2352x1568
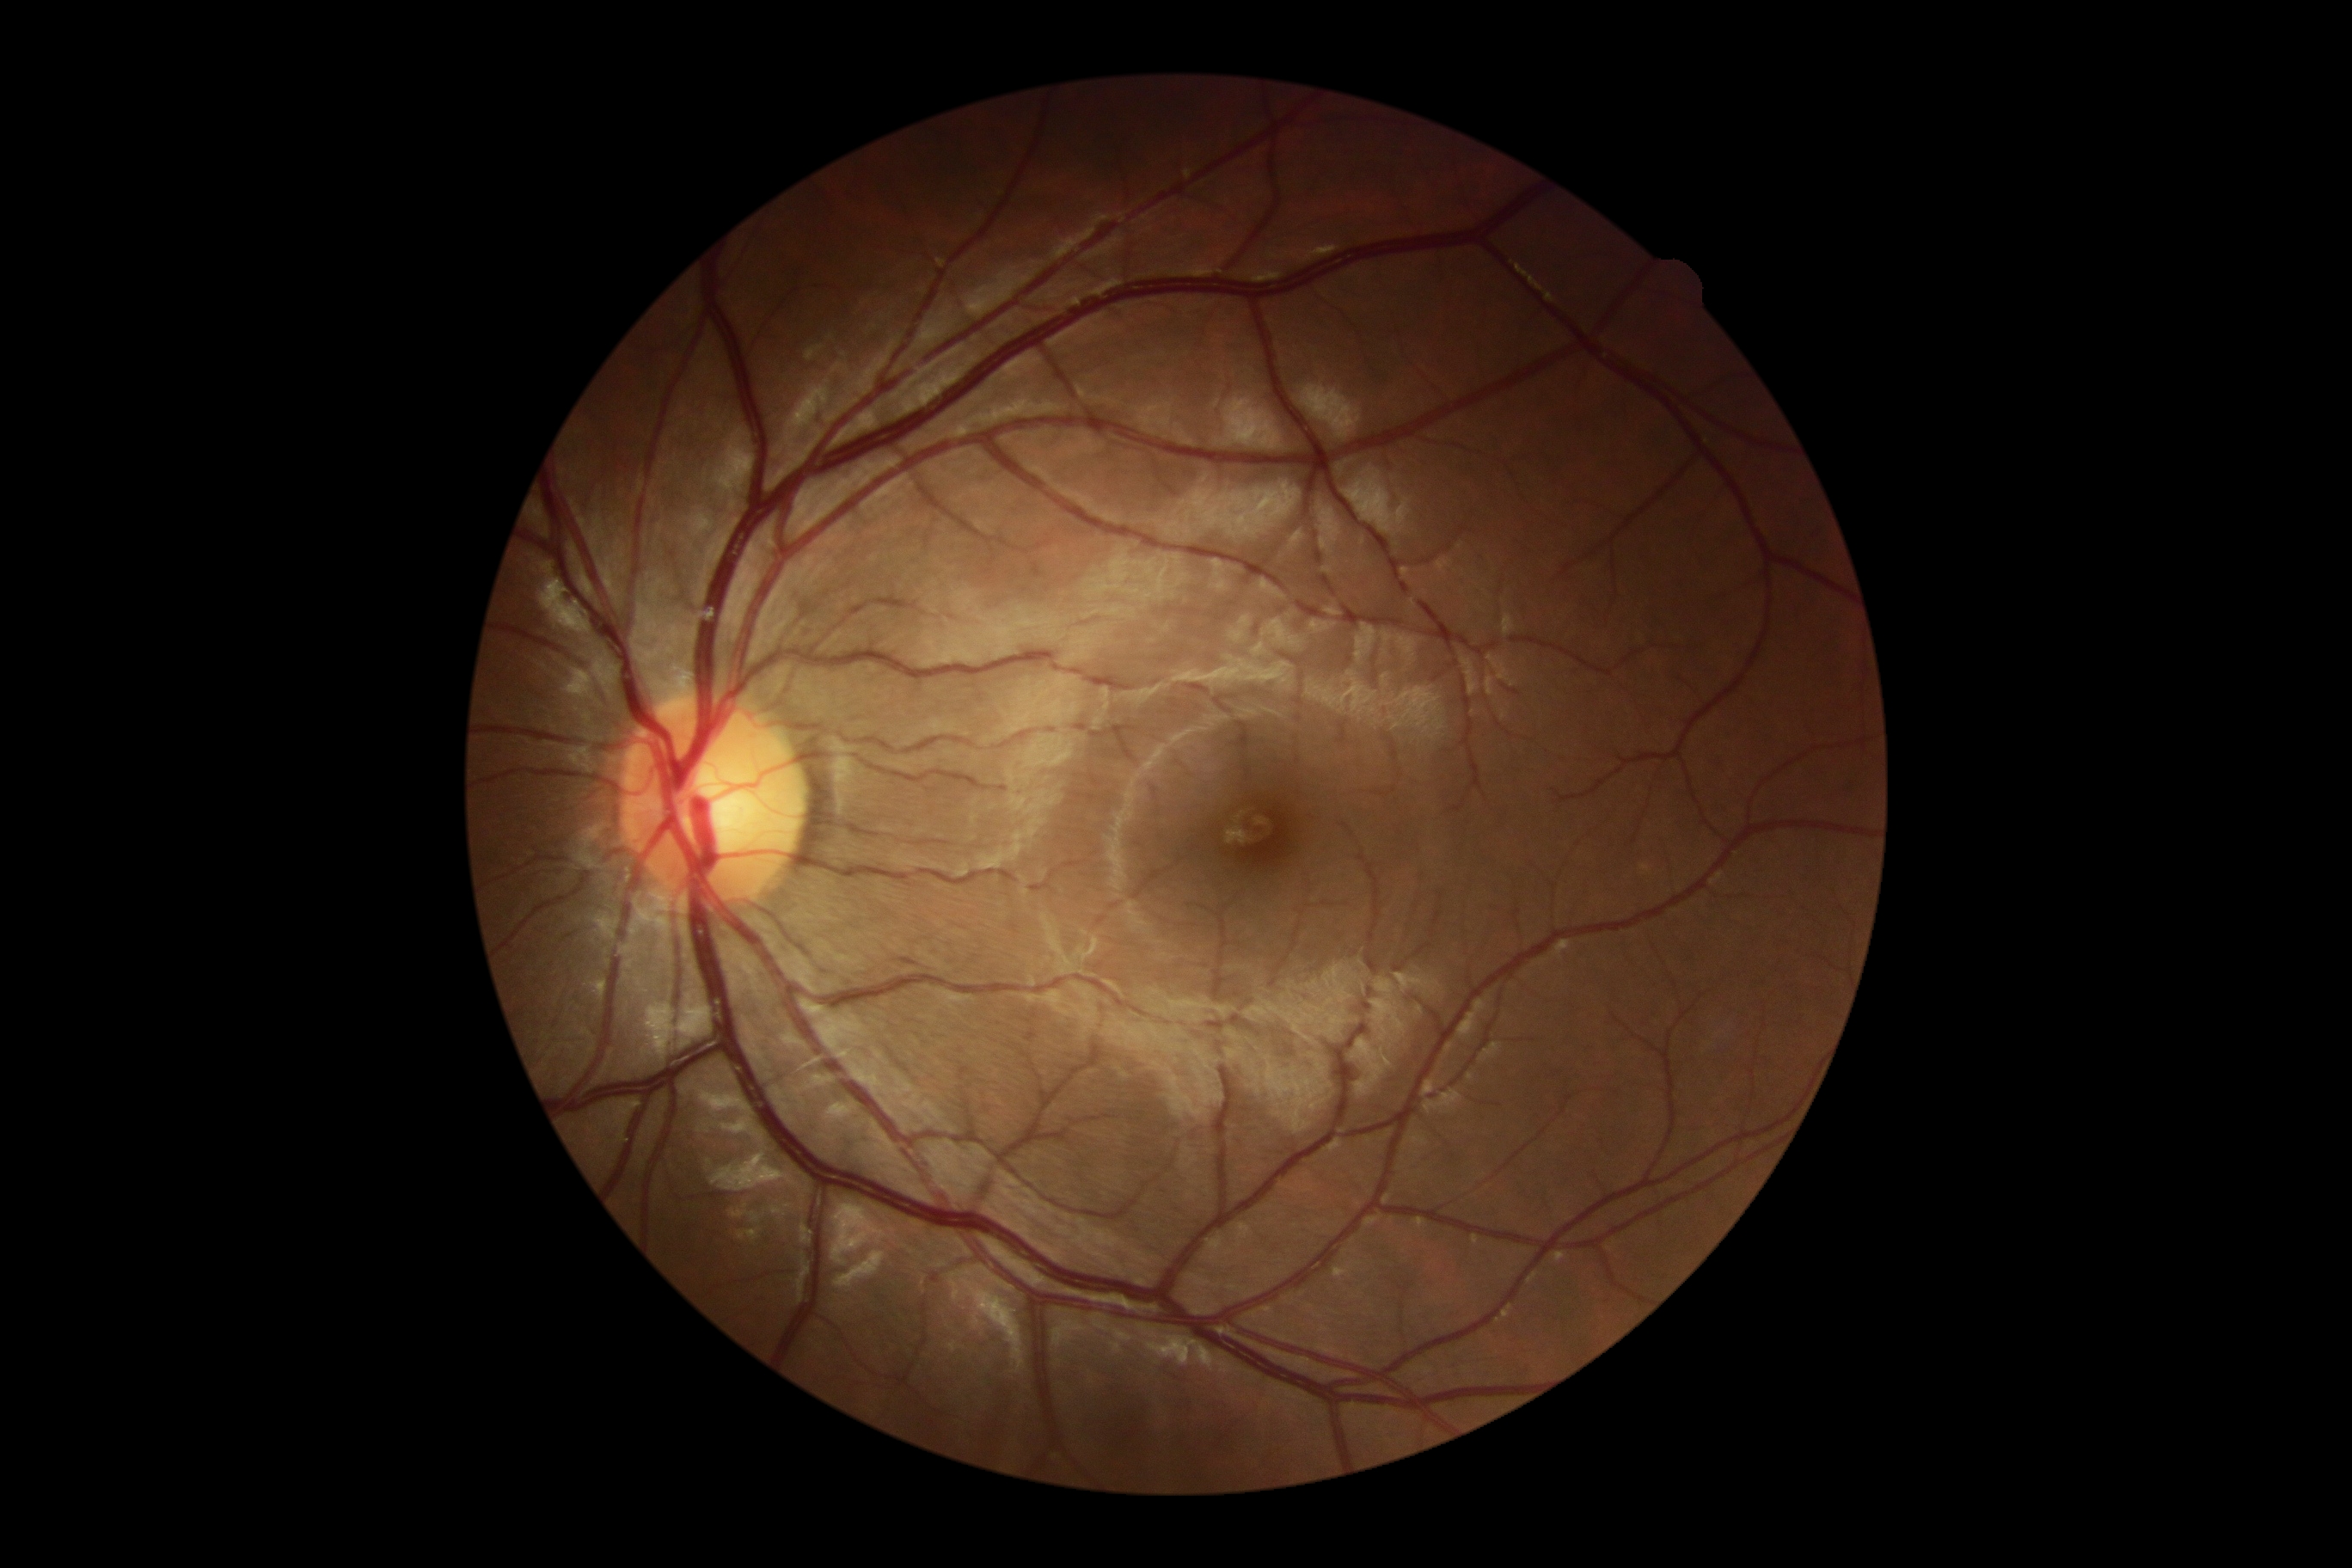
DR grade is 0 (no apparent retinopathy) — no visible signs of diabetic retinopathy.